Pupil-dilated.
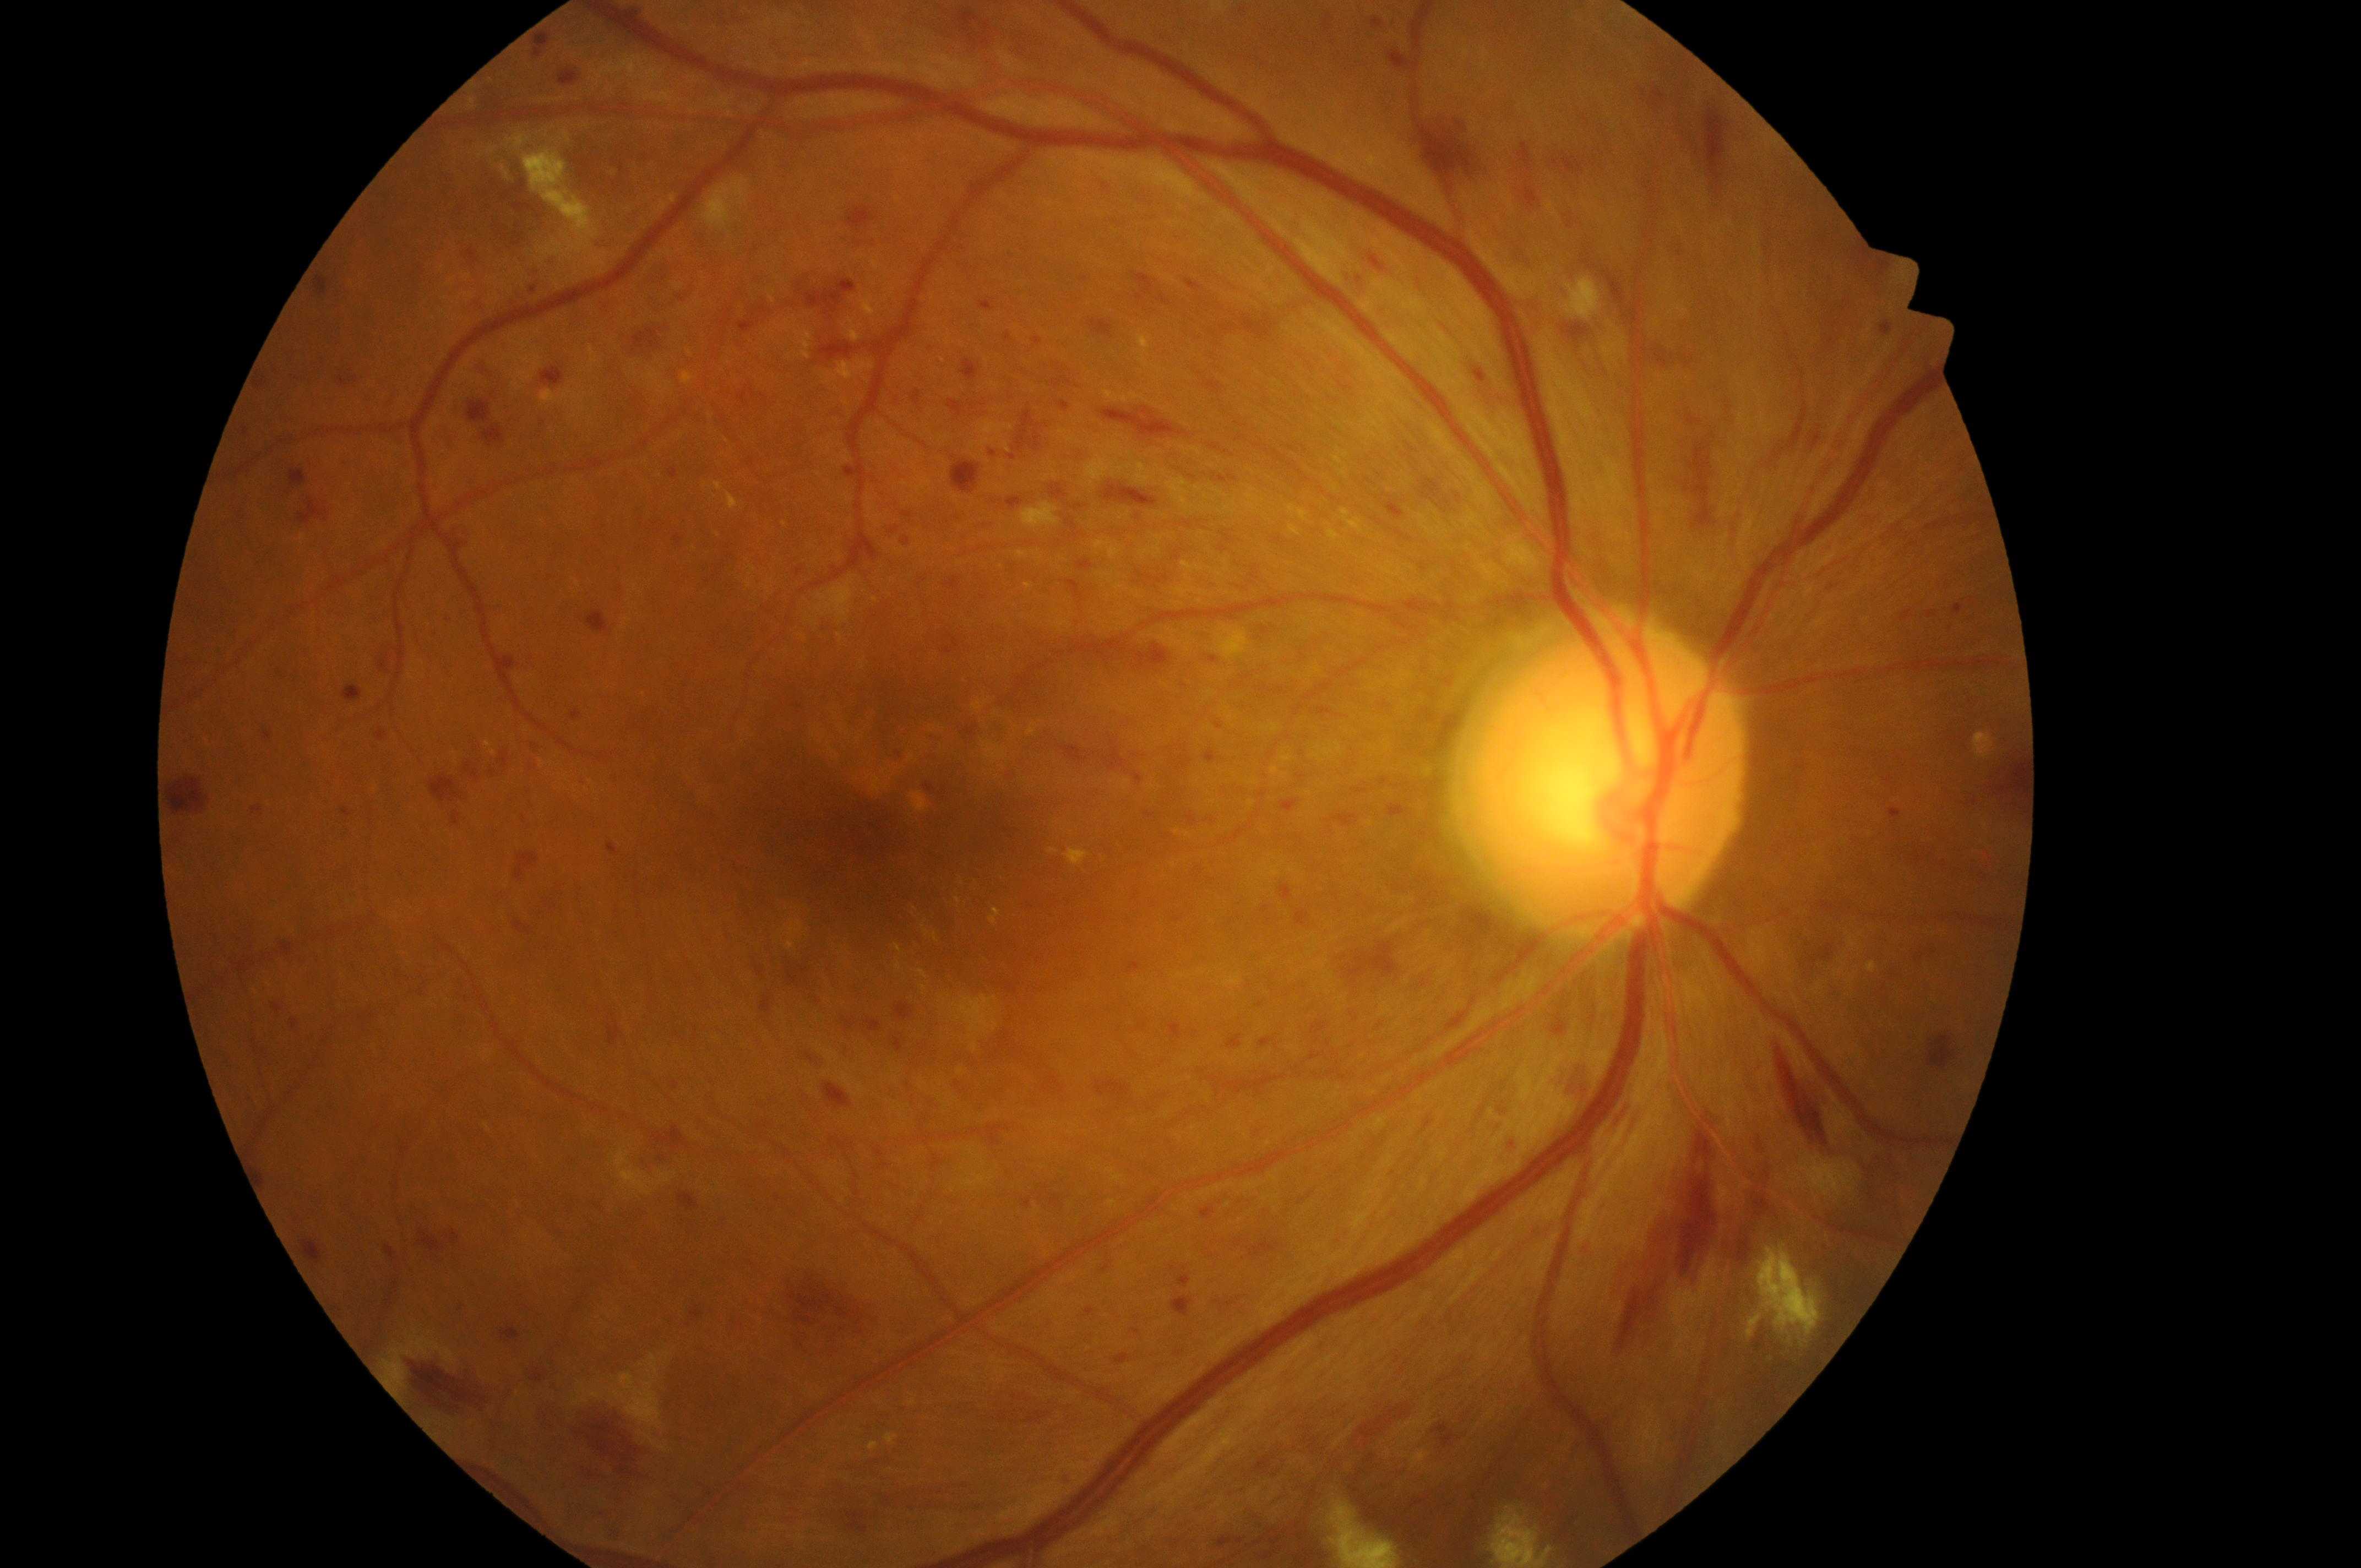
Q: Locate the optic disc.
A: 1603px, 790px
Q: What is the laterality?
A: the right eye
Q: DR stage?
A: 3/4
Q: Fovea center?
A: 871px, 839px
Q: What is the DME risk grade?
A: 2
Q: What disease class is present?
A: non-proliferative diabetic retinopathy